Wide-field fundus image from infant ROP screening · image size 1440x1080 · camera: Natus RetCam Envision (130° FOV):
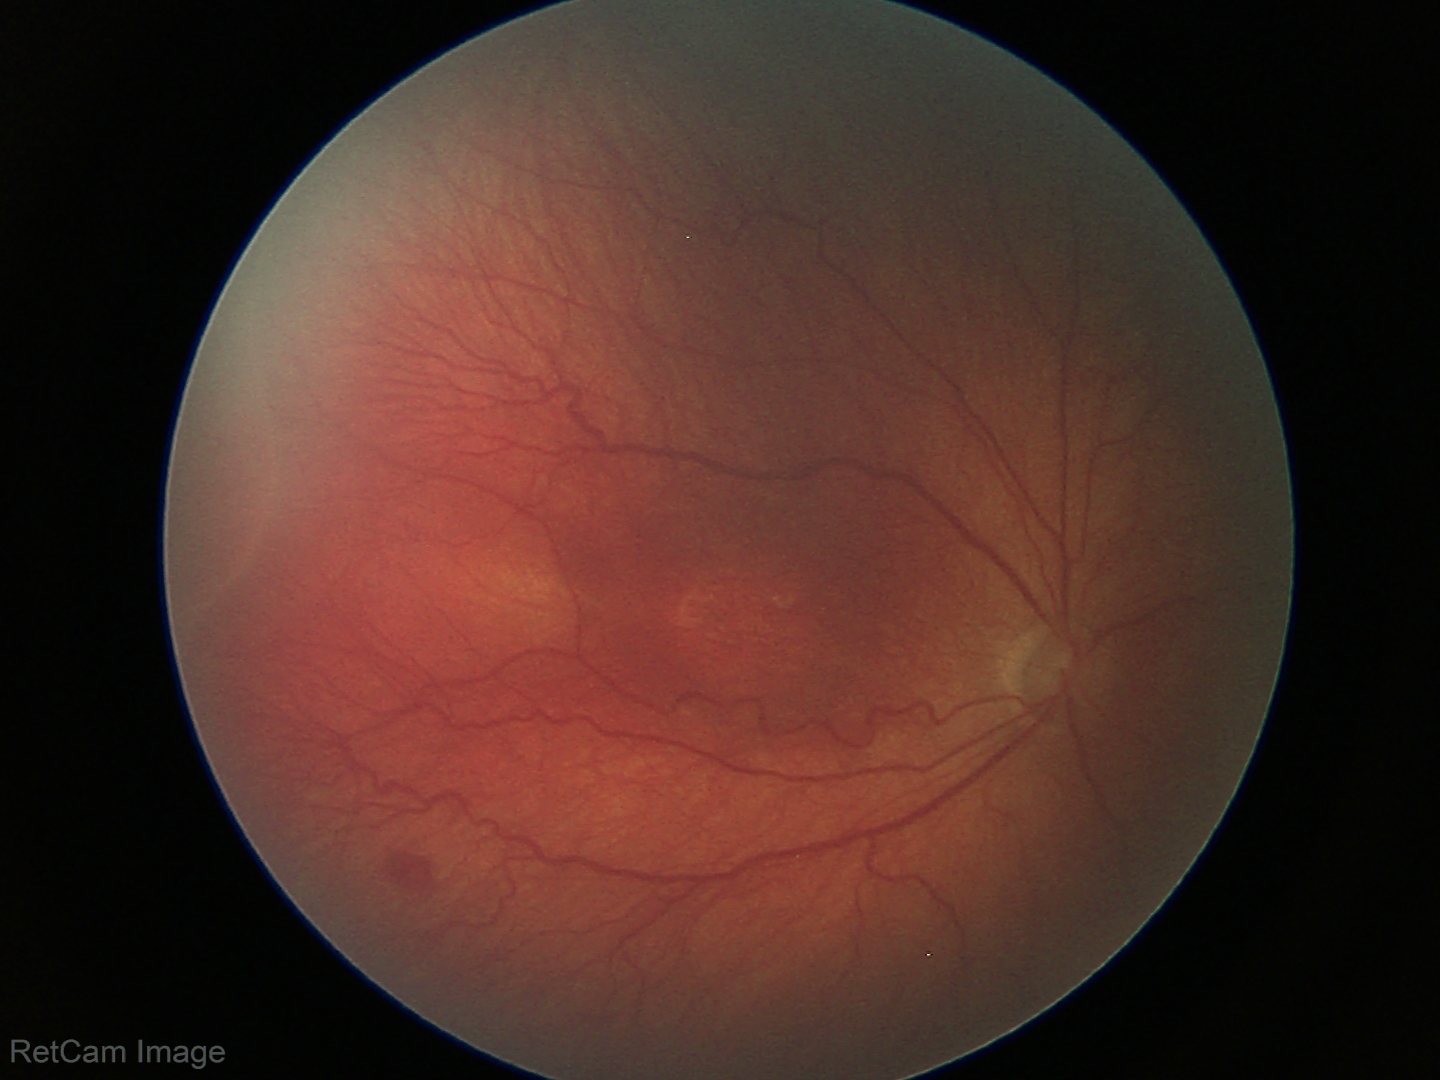

Assessment: ROP stage 3.